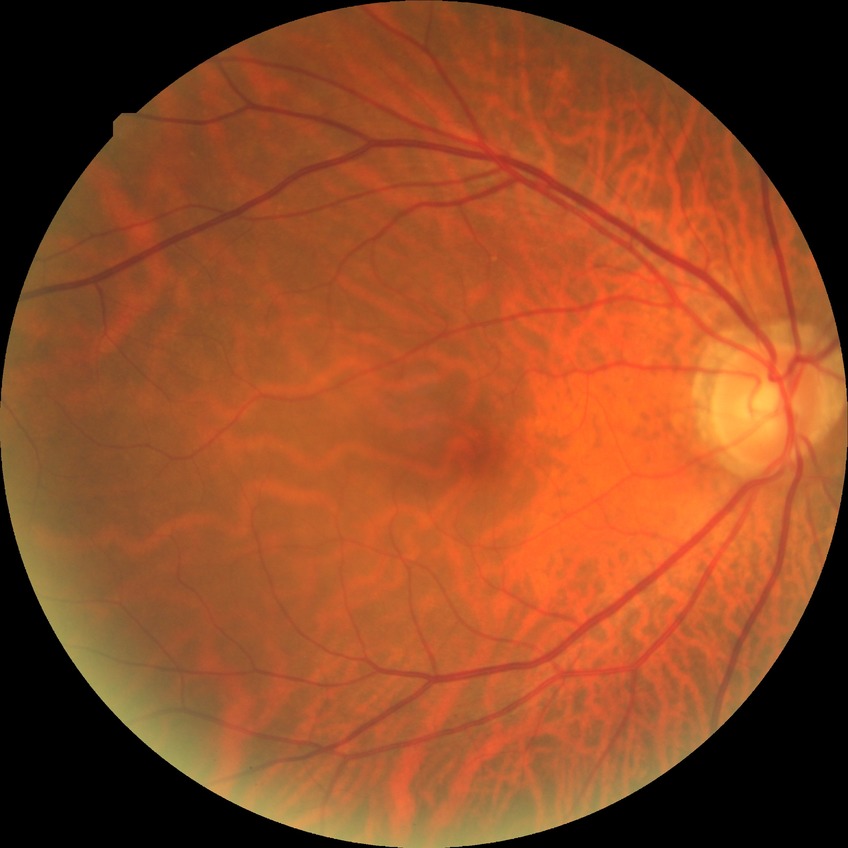 Diabetic retinopathy severity: no diabetic retinopathy.